848 x 848 pixels. No pharmacologic dilation.
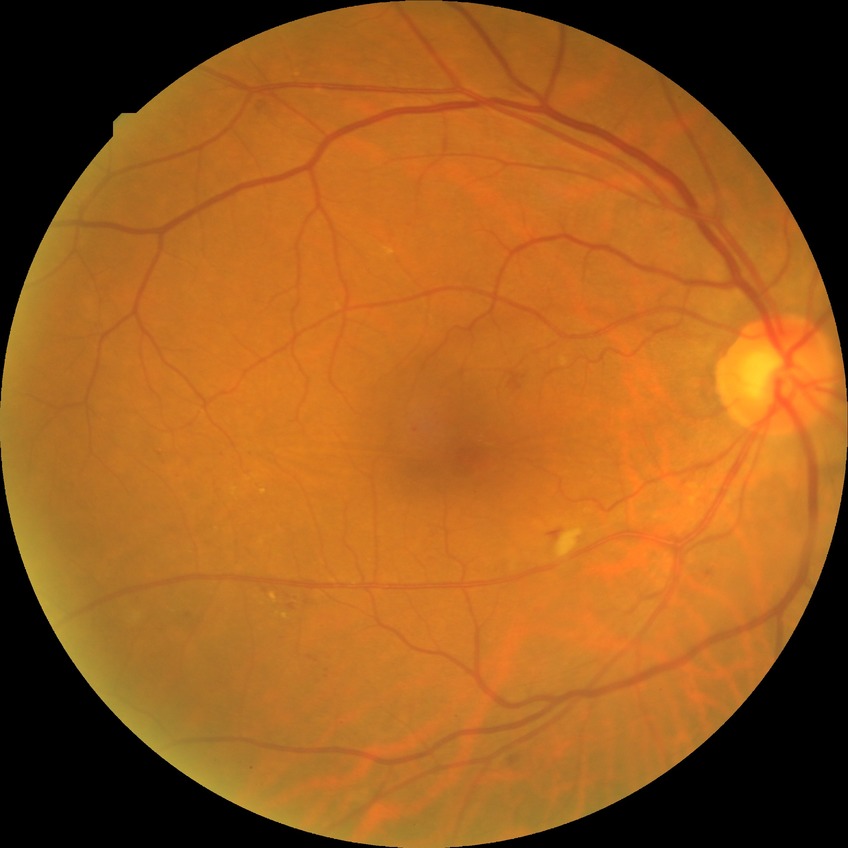
DR = SDR